RetCam wide-field infant fundus image:
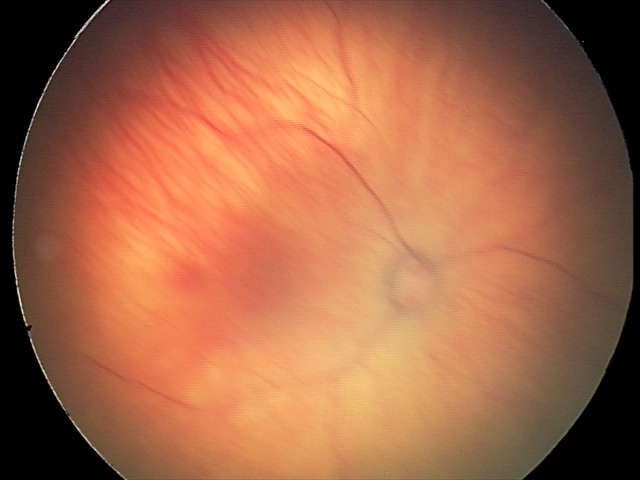

From an examination with diagnosis of retinal hemorrhages.